240 by 240 pixels — 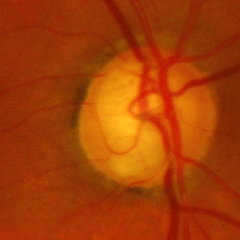

Advanced-stage glaucoma.